NIDEK AFC-230 fundus camera, graded on the modified Davis scale, 848 by 848 pixels — 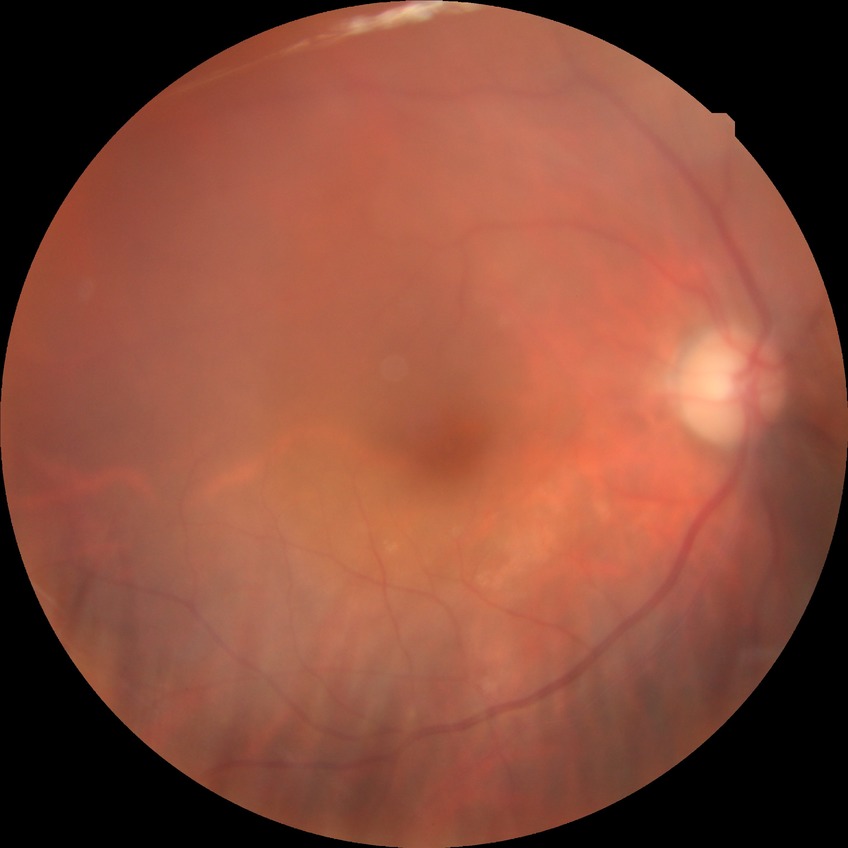

  davis_grade: NDR (no diabetic retinopathy)